50-degree field of view. Fundus photo — 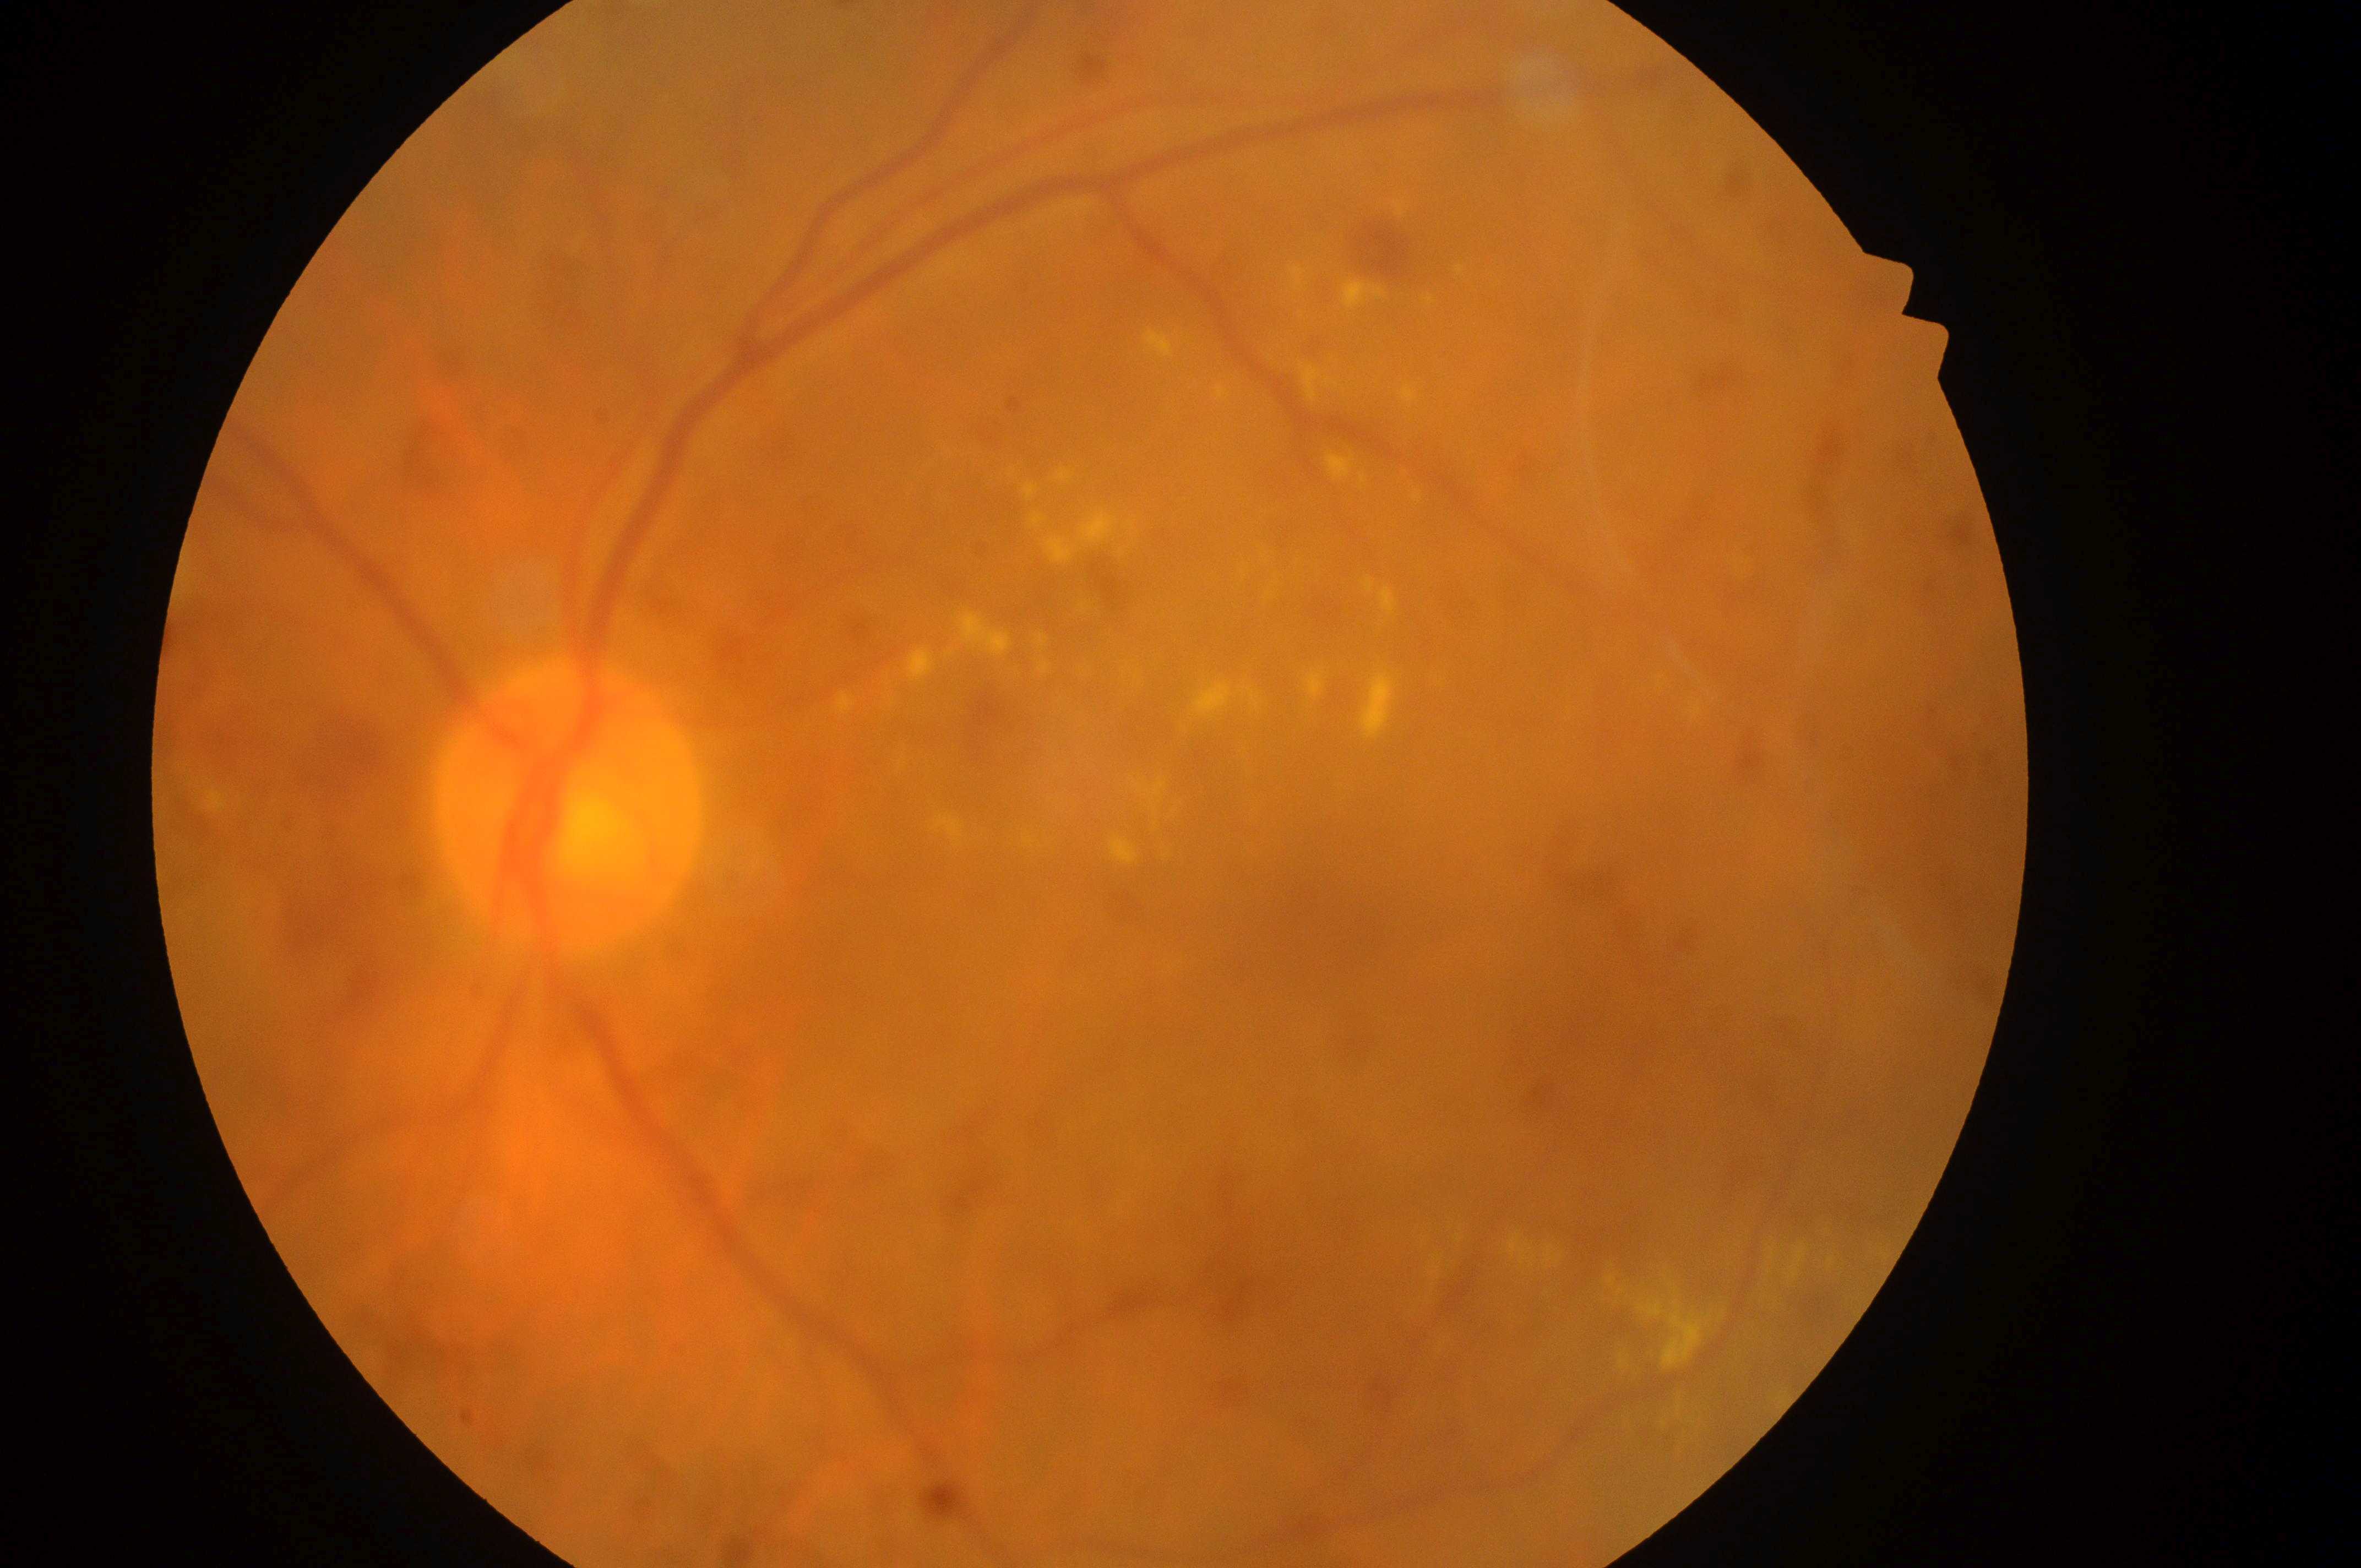 DR grade = severe NPDR (3); laterality = left eye; optic disk = (561,820); DME = grade 2 (high risk); macula center = (1341,942).